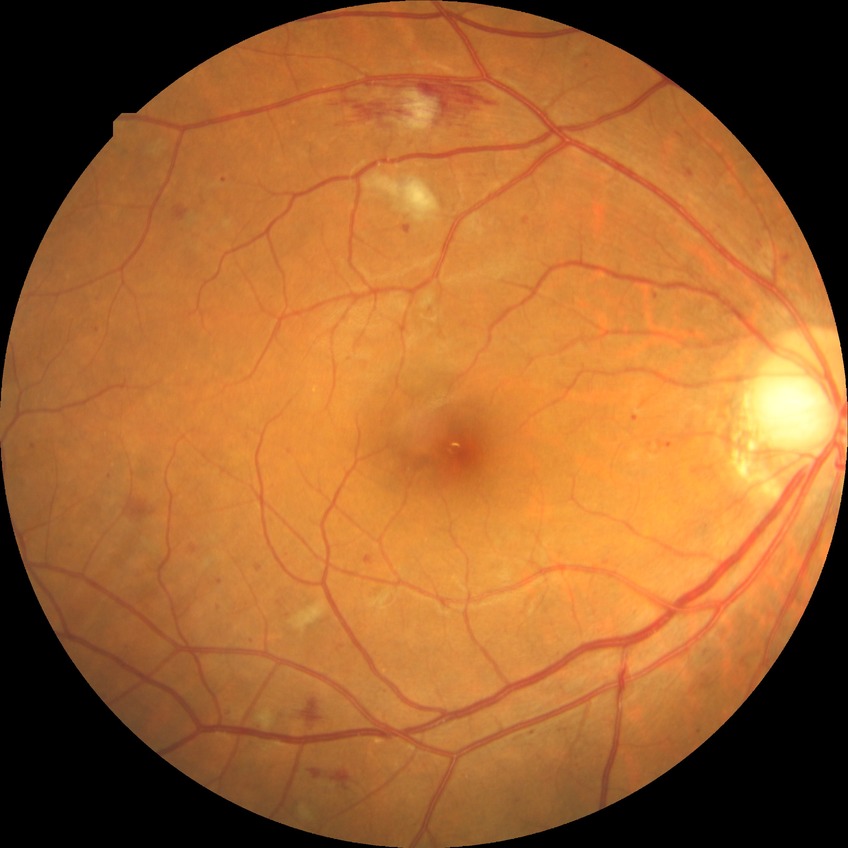

Diabetic retinopathy (DR): PPDR (pre-proliferative diabetic retinopathy).